Color fundus photograph · 2346 by 1568 pixels · 45° field of view
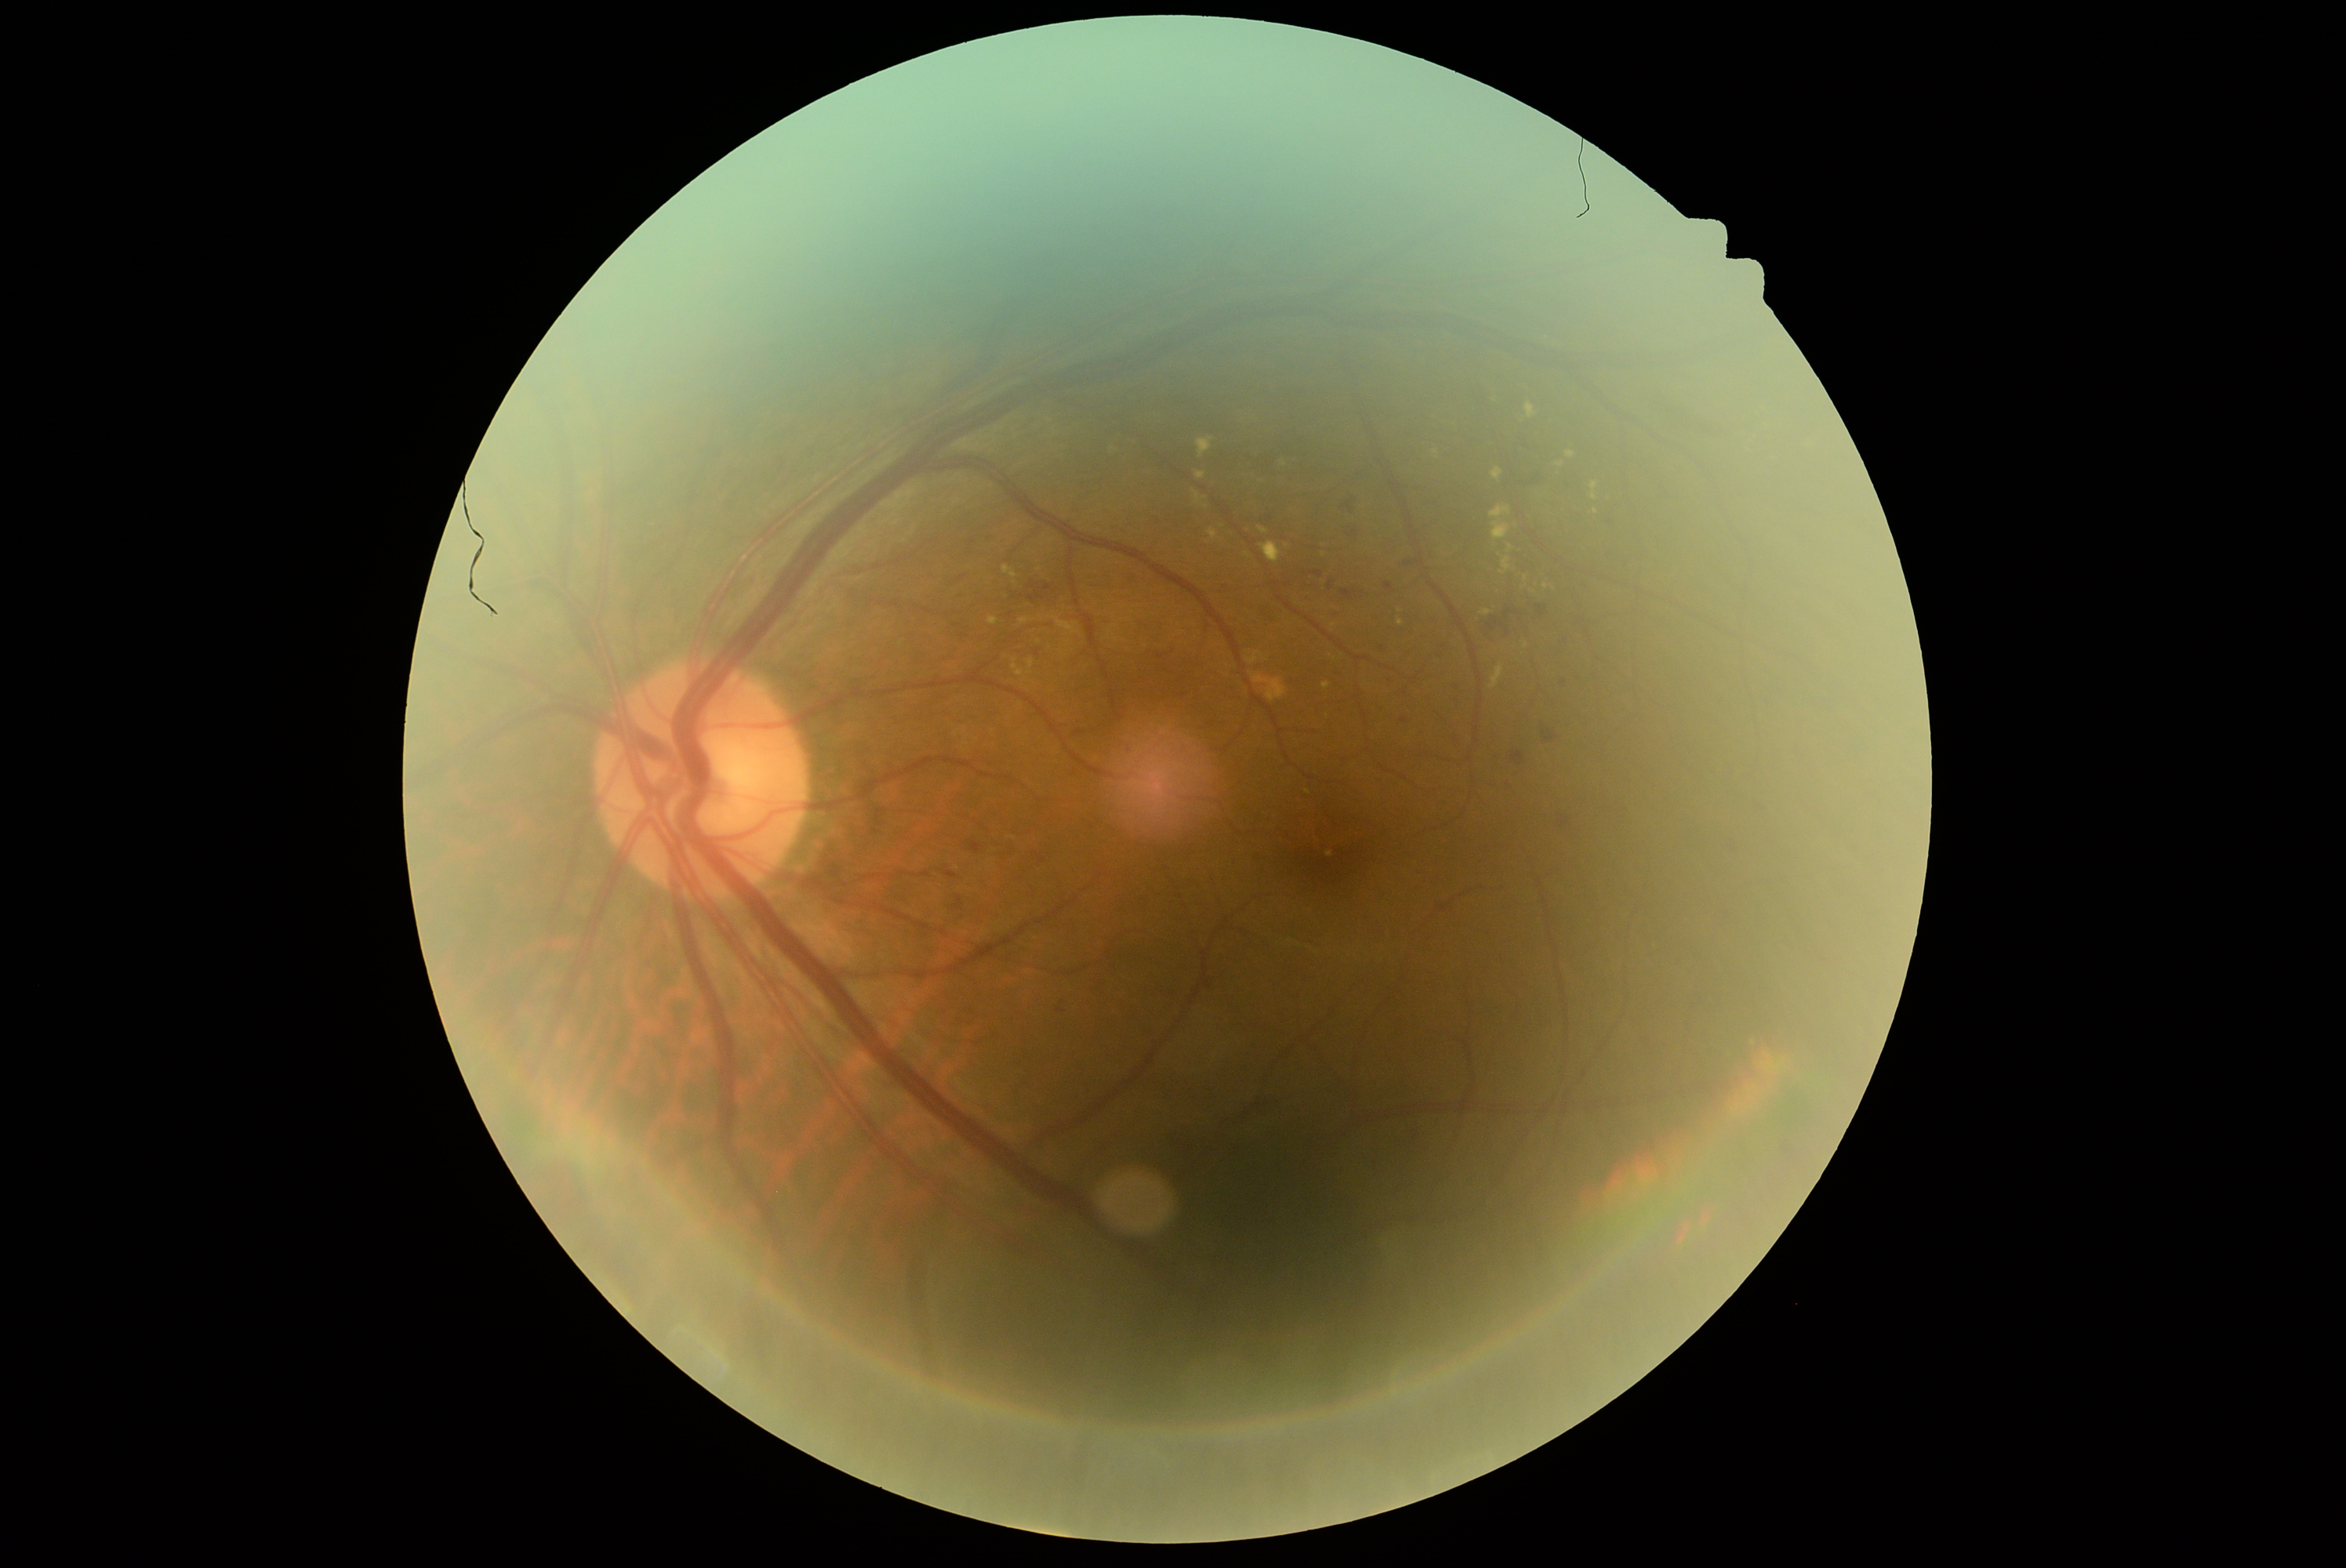

diabetic retinopathy = 2.